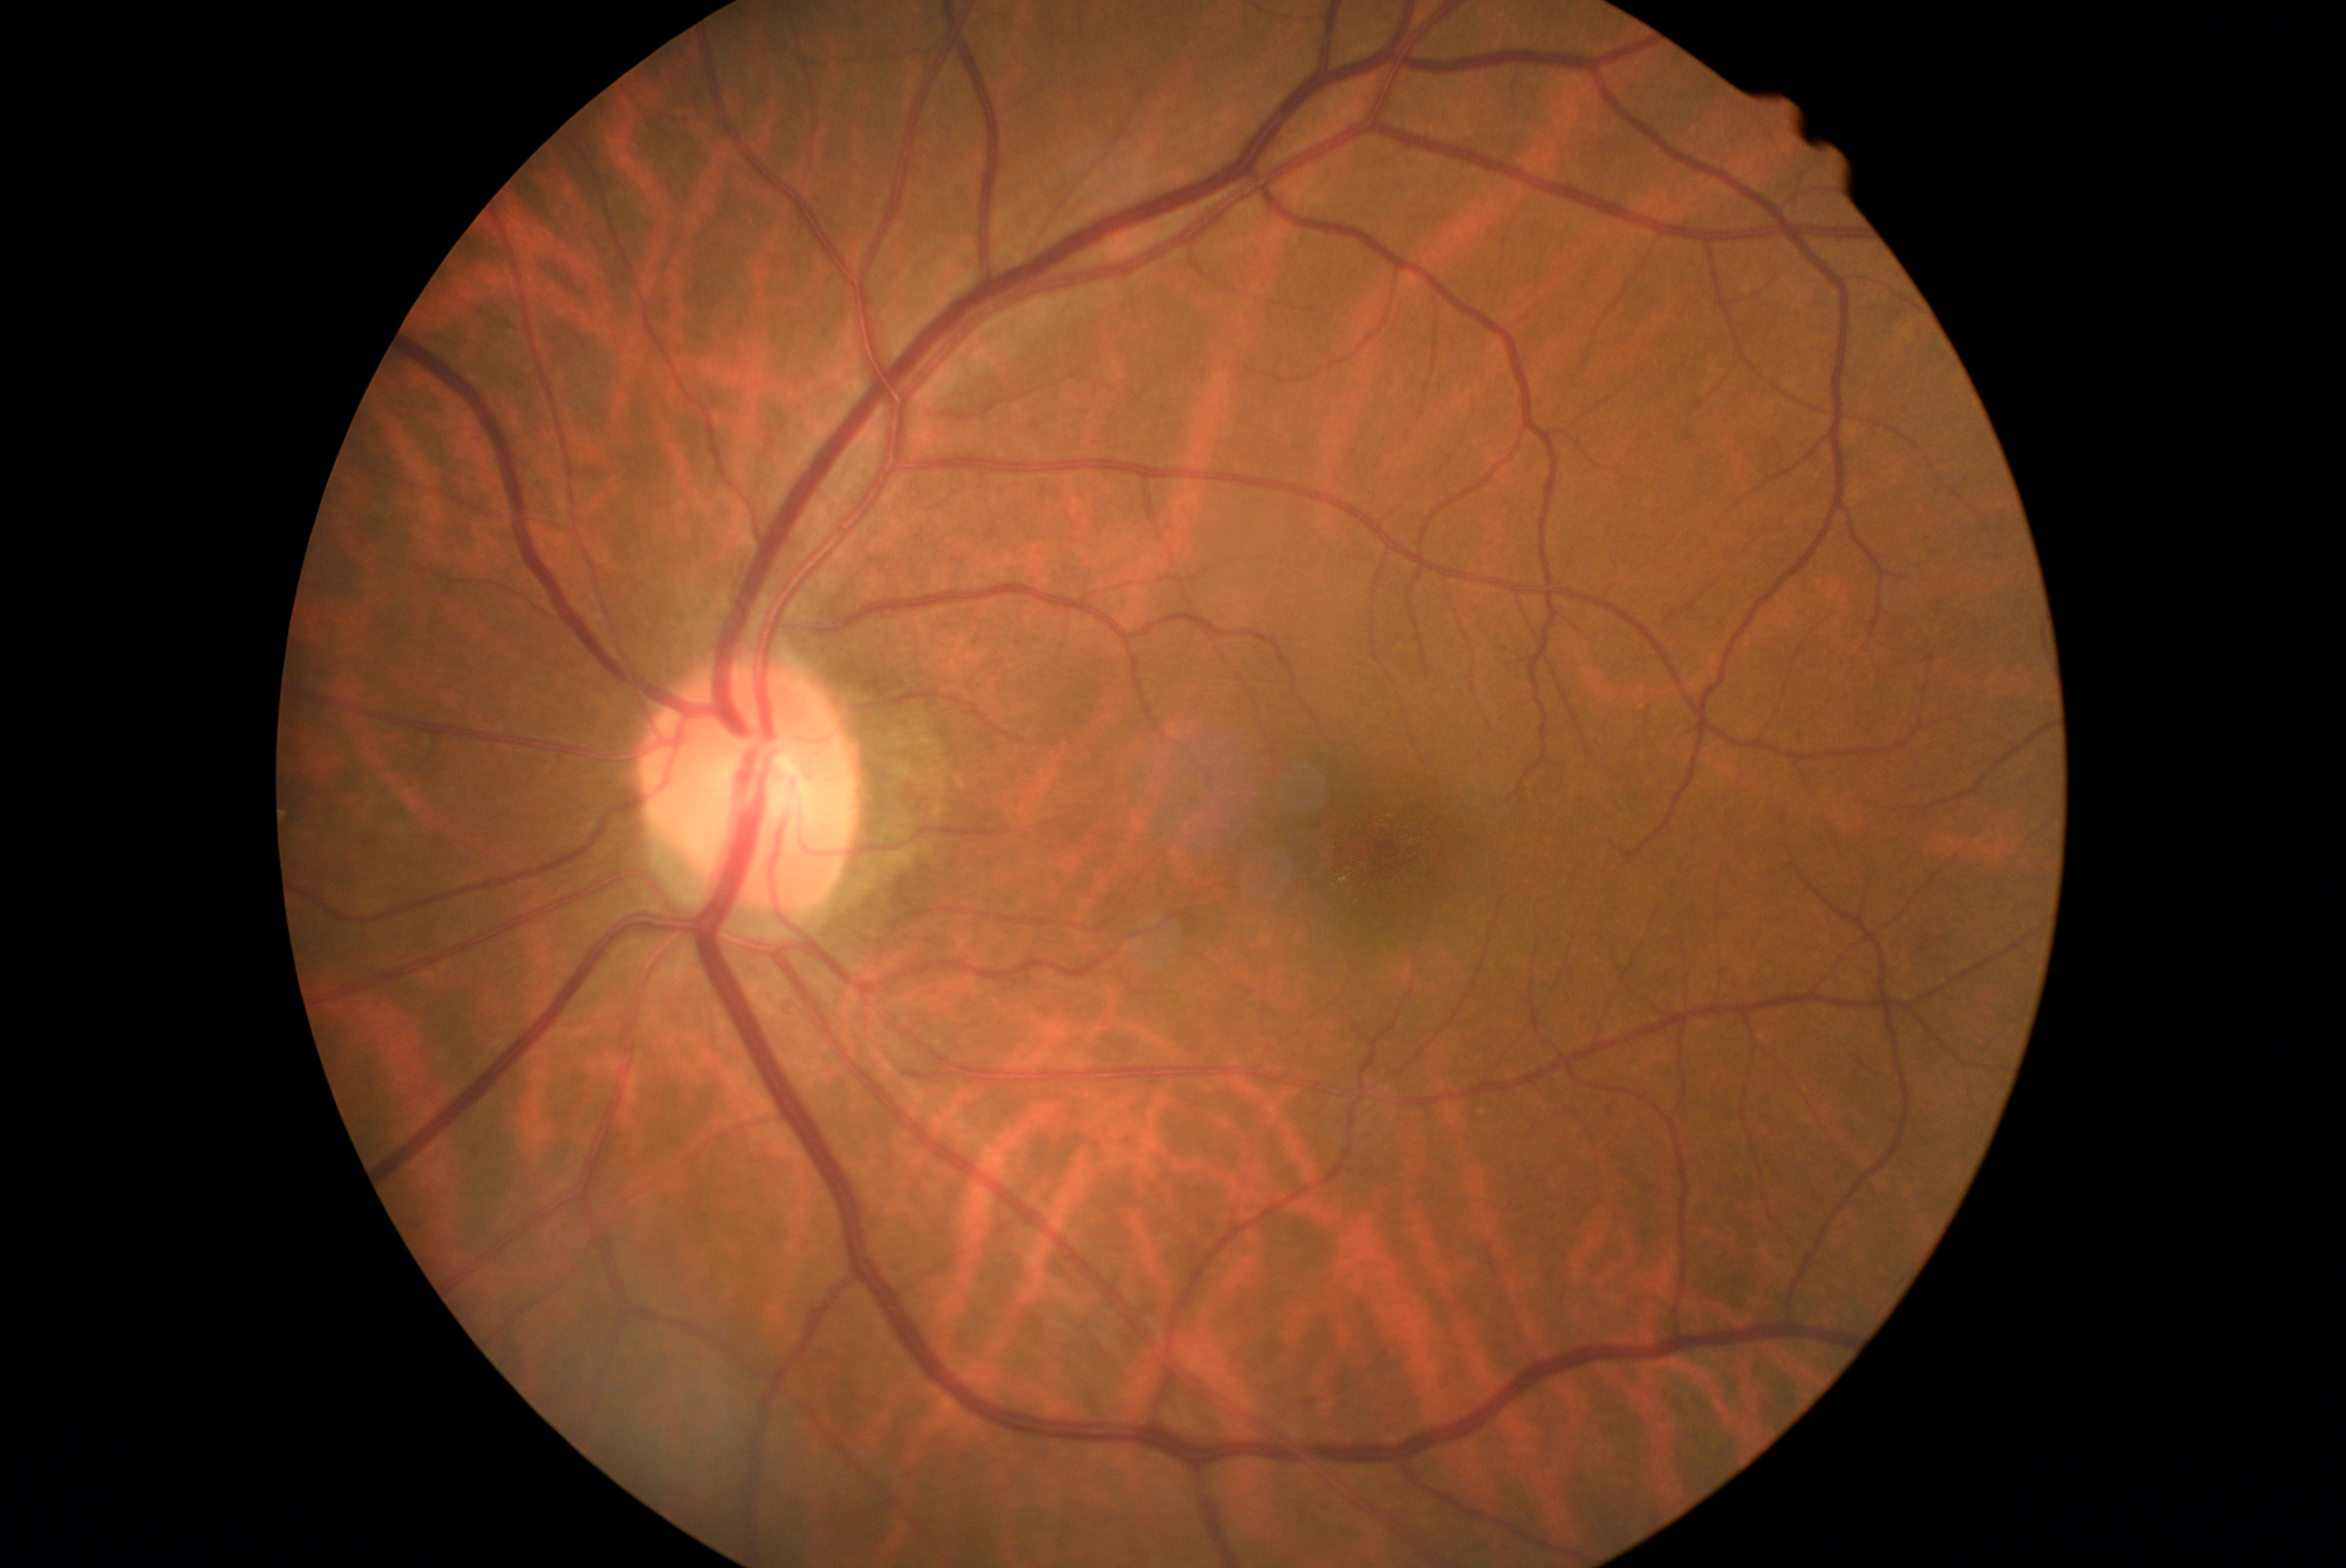
DR grade: 0 (no apparent retinopathy).